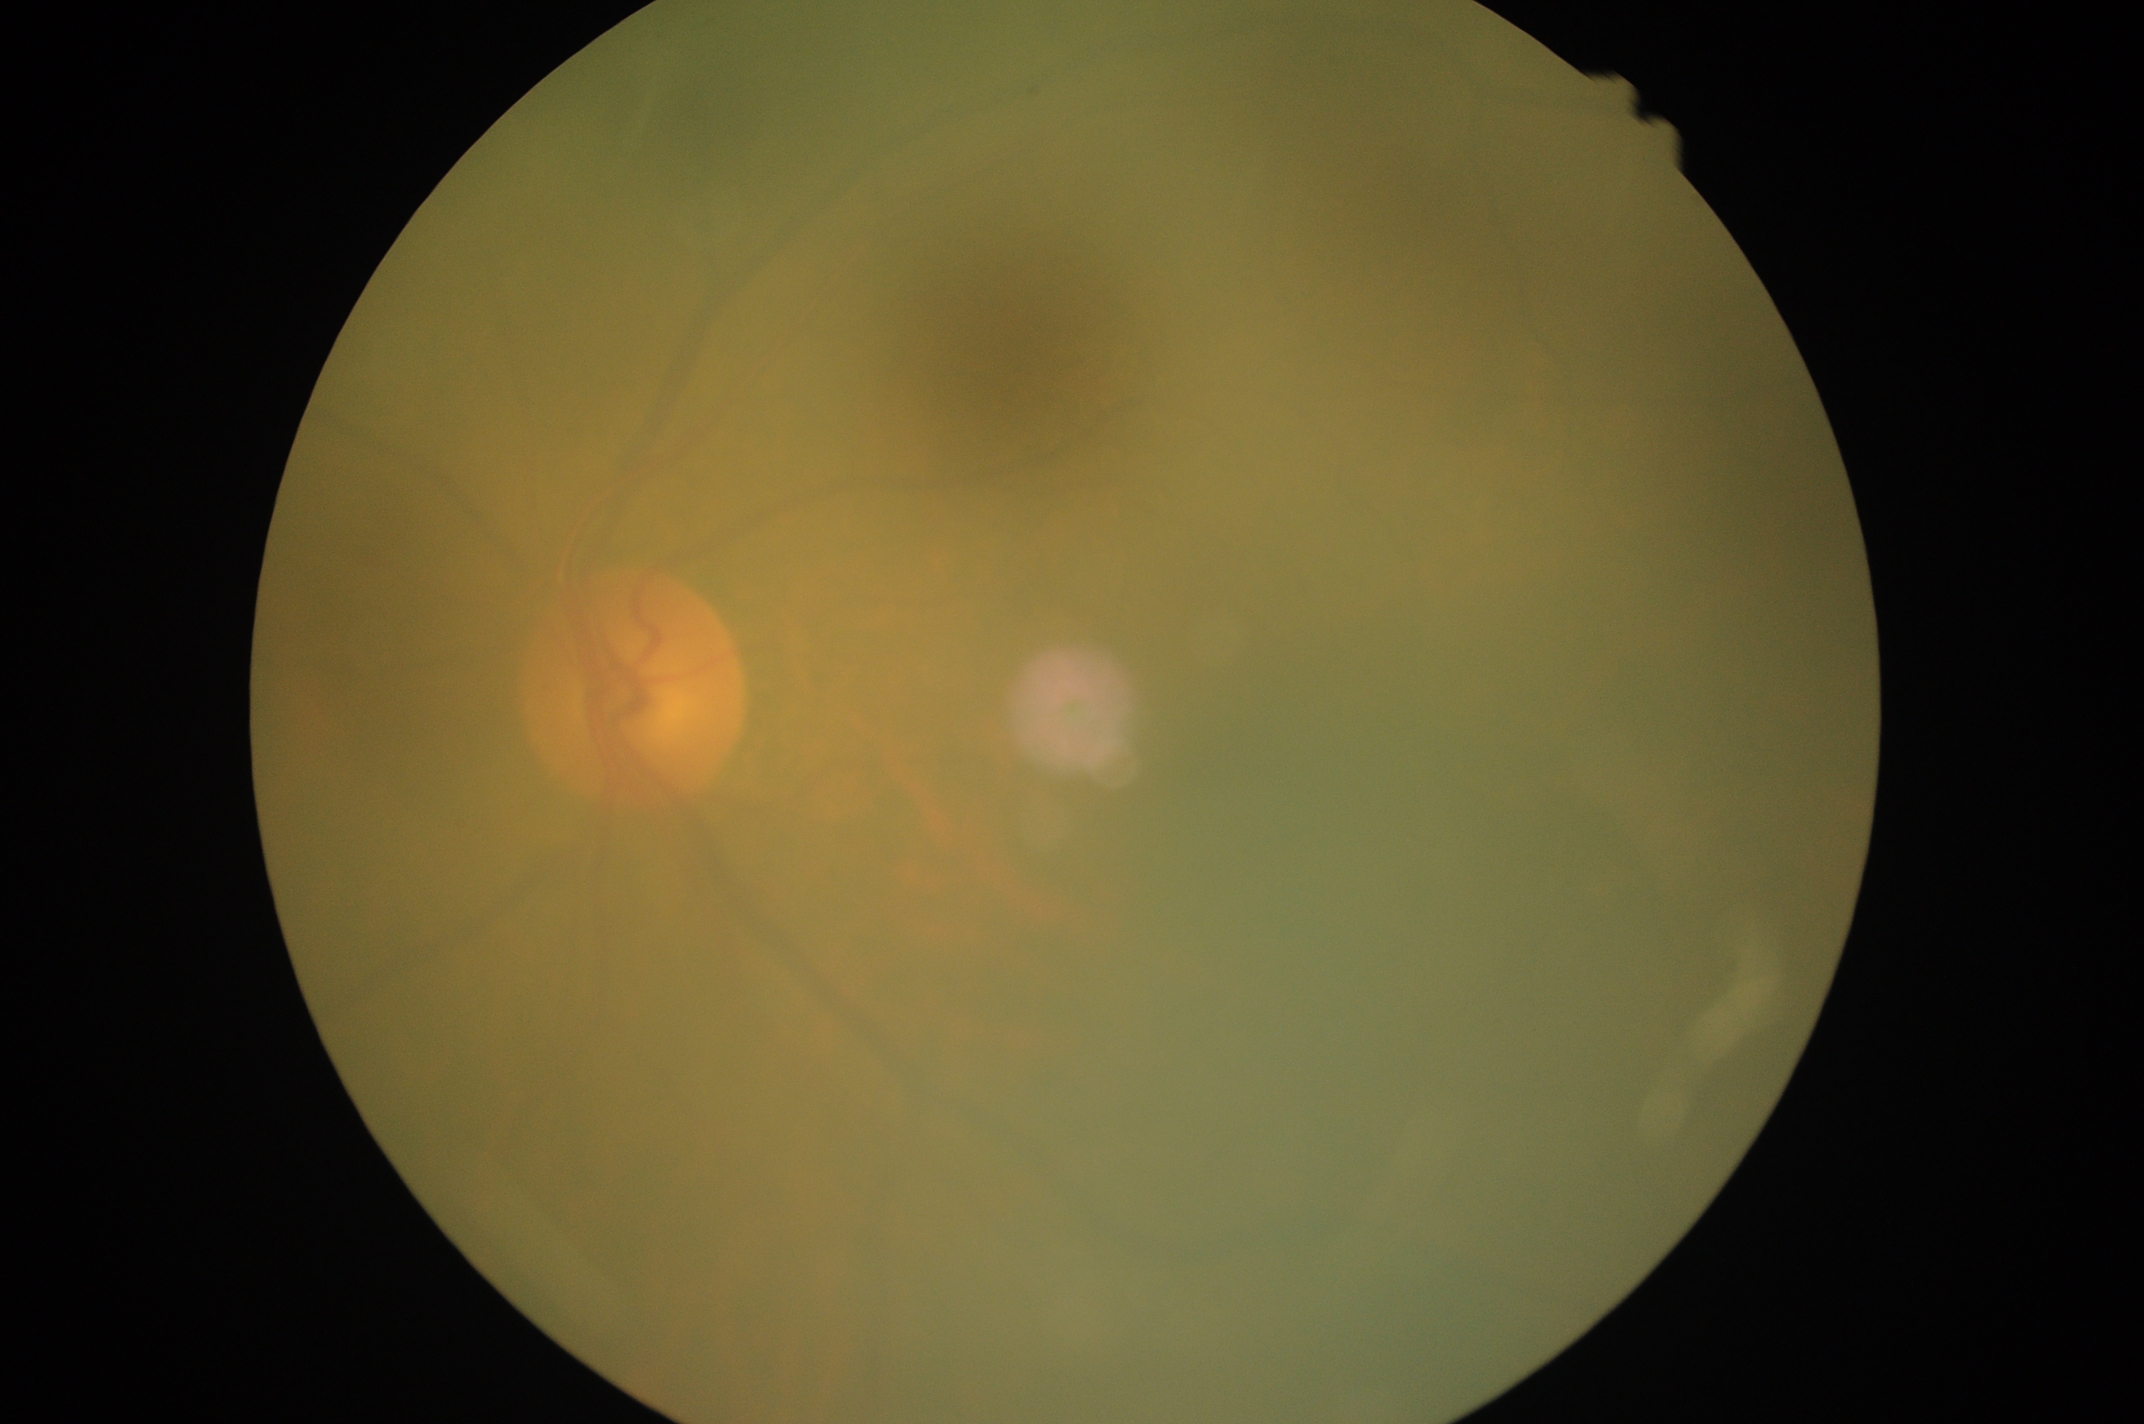 DR severity@grade 0 (no apparent retinopathy).